2352x1568px.
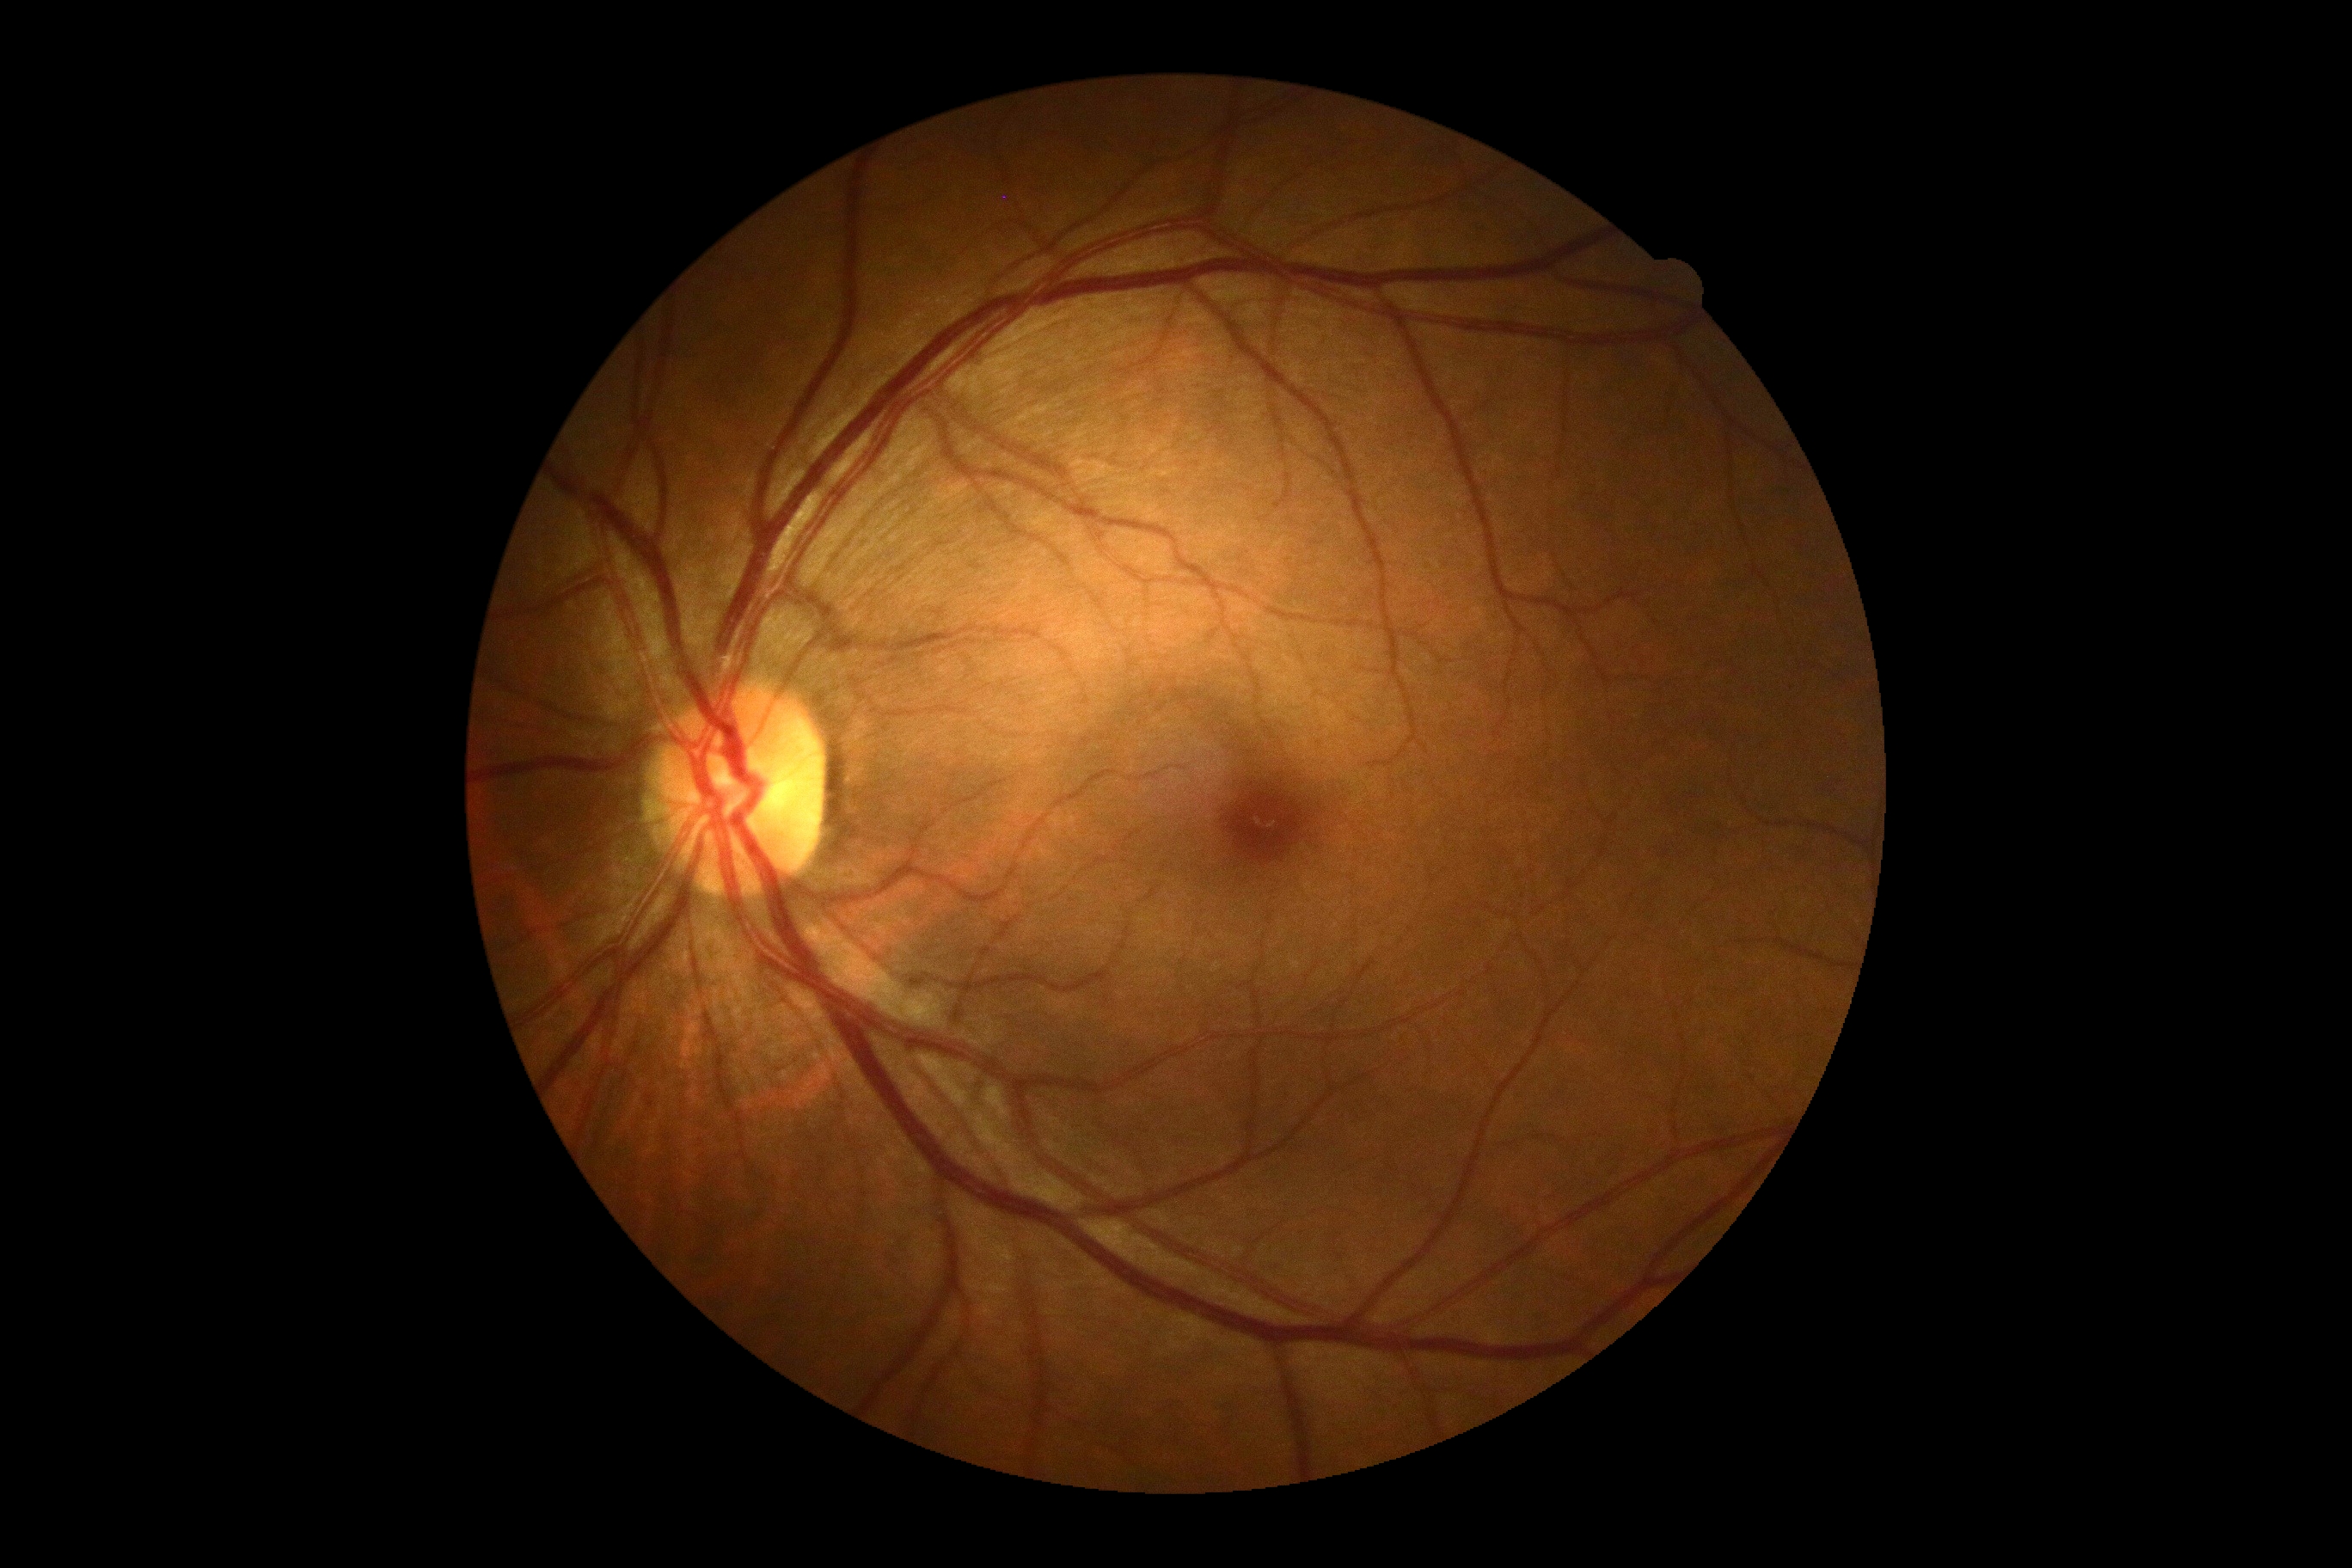
No diabetic retinal disease findings.
Retinopathy grade: no apparent diabetic retinopathy (0).